Color fundus photograph, 2212x1659px: 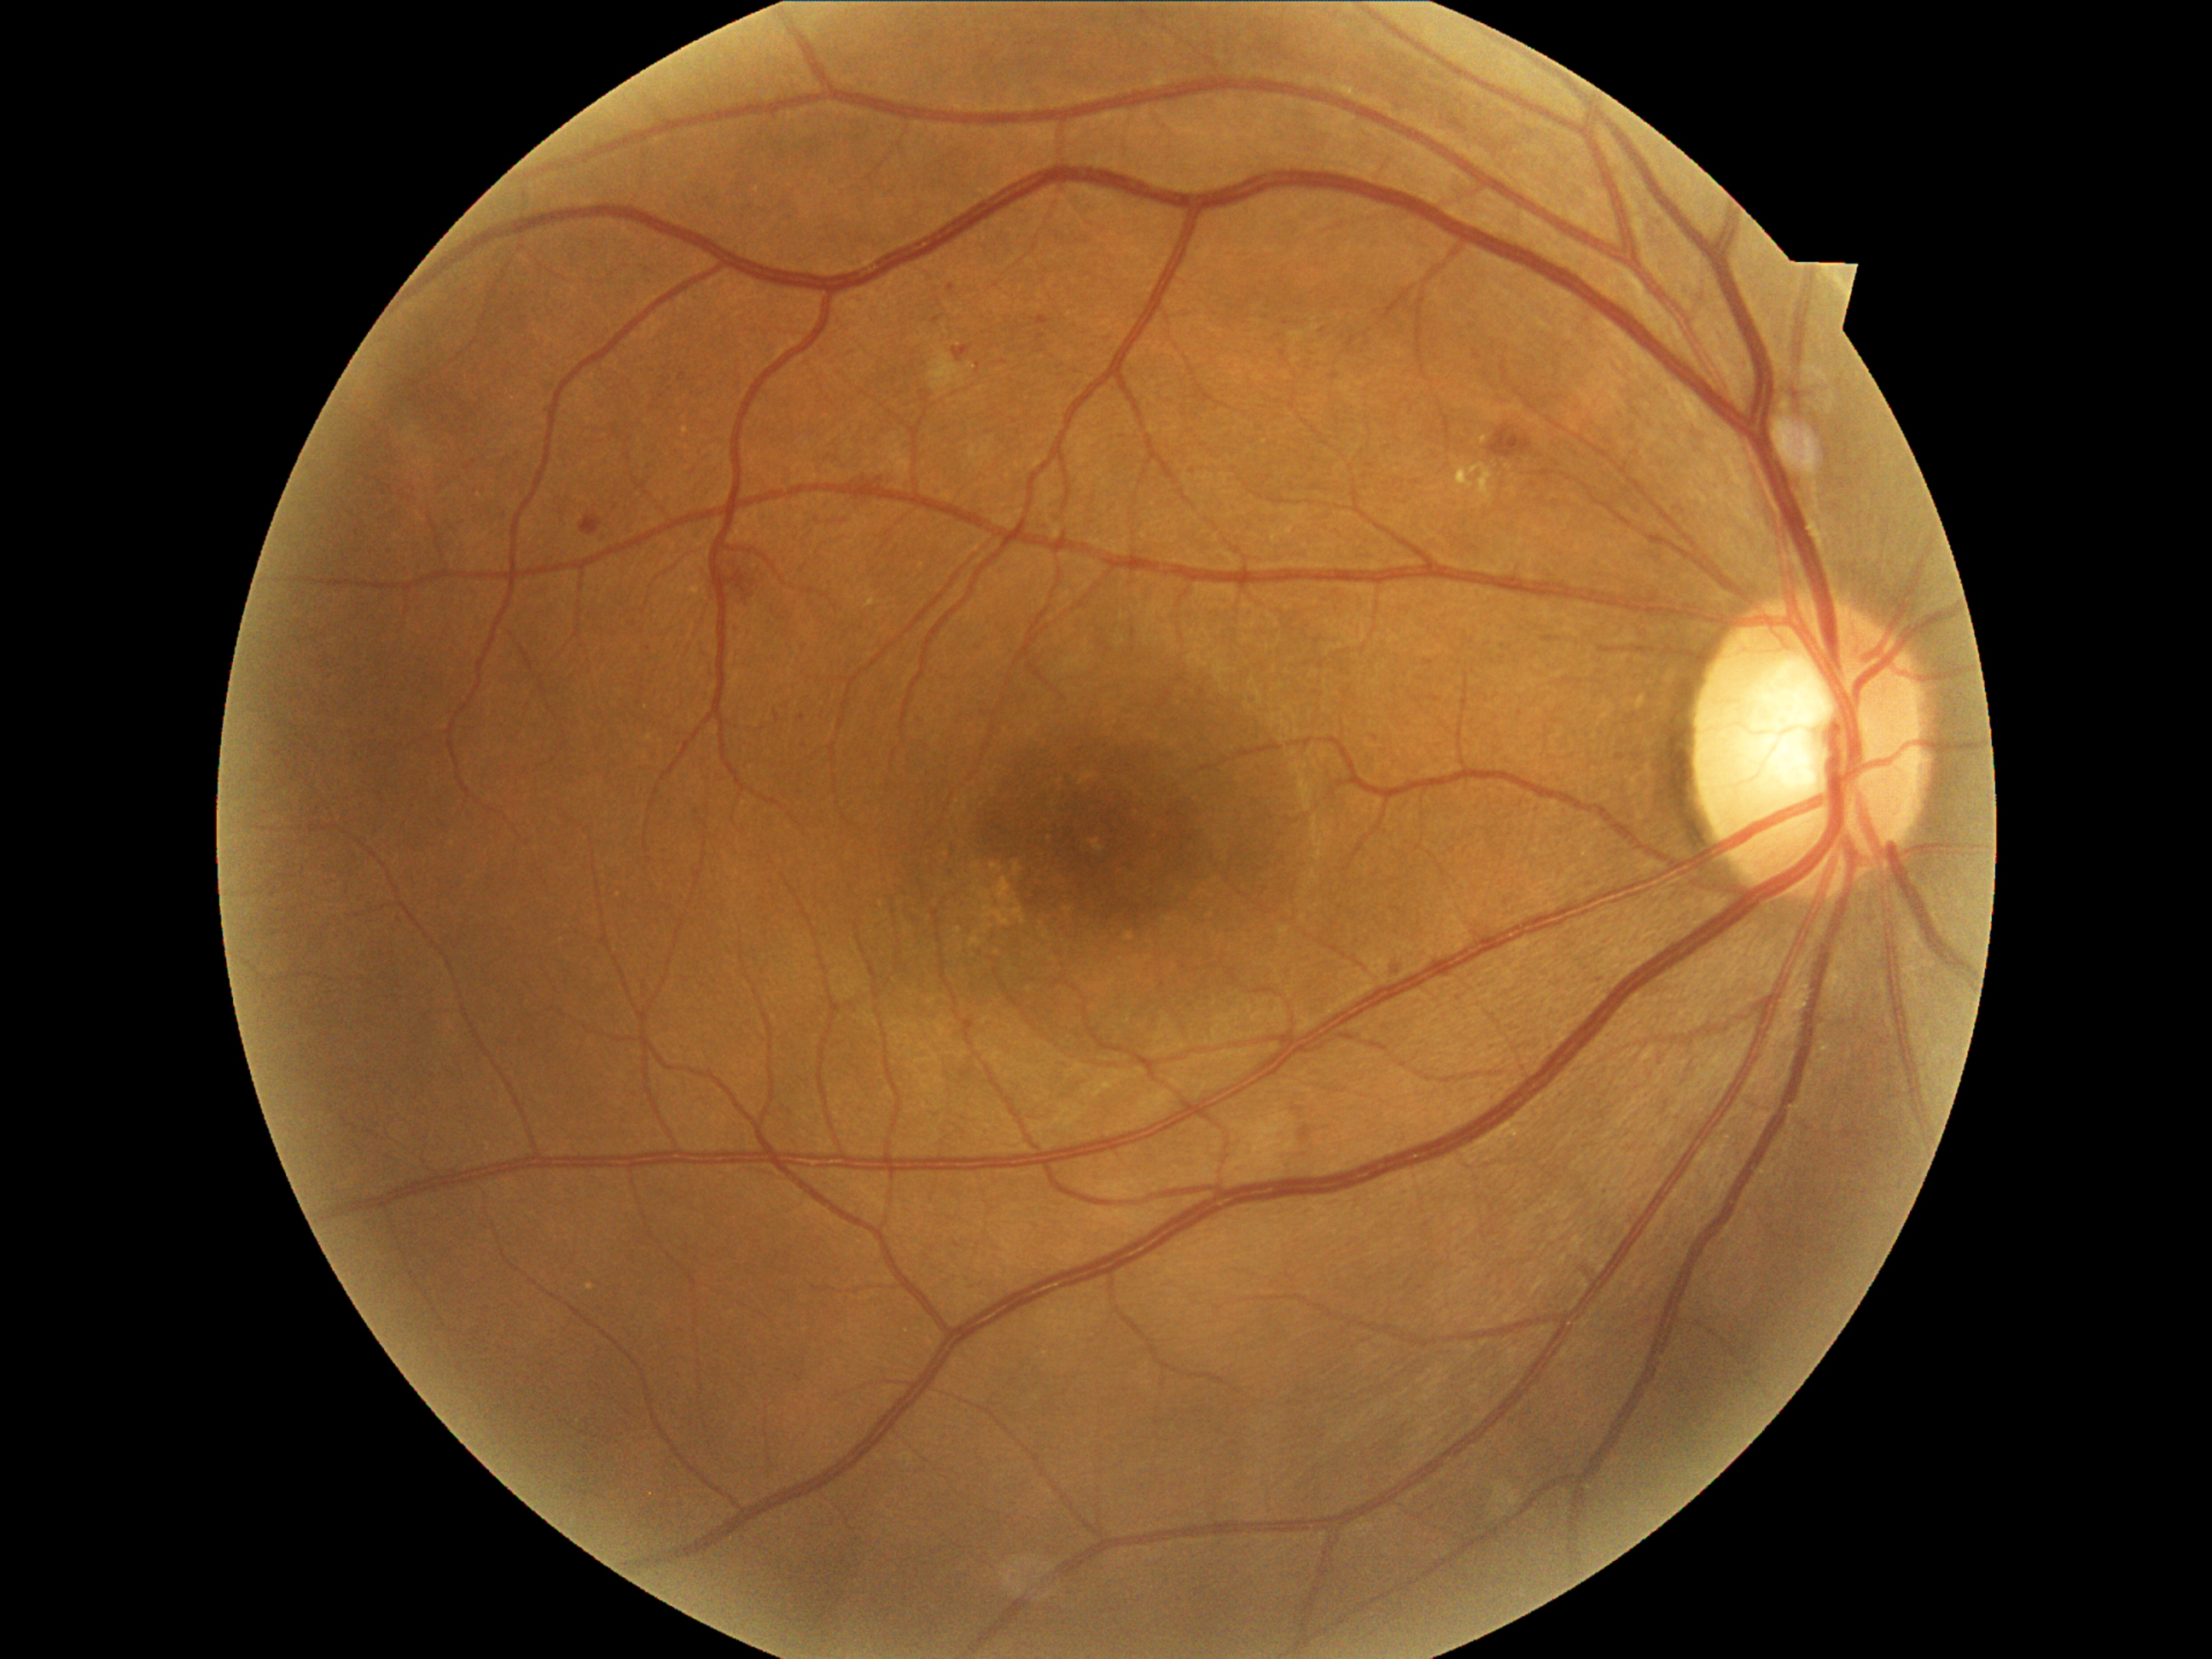 DR: grade 2
EXs: Rect(1482, 436, 1487, 445) | Rect(1457, 463, 1494, 509)
SEs: Rect(929, 351, 967, 390)
HEs: Rect(721, 568, 755, 602) | Rect(851, 474, 883, 494) | Rect(579, 515, 603, 537) | Rect(1489, 426, 1530, 458)
MAs: Rect(1474, 351, 1482, 359) | Rect(1037, 317, 1051, 327) | Rect(774, 713, 781, 723) | Rect(953, 347, 972, 363)
Additional small MAs near 1397, 970 | 803, 717 | 804, 745 | 952, 287